848x848px
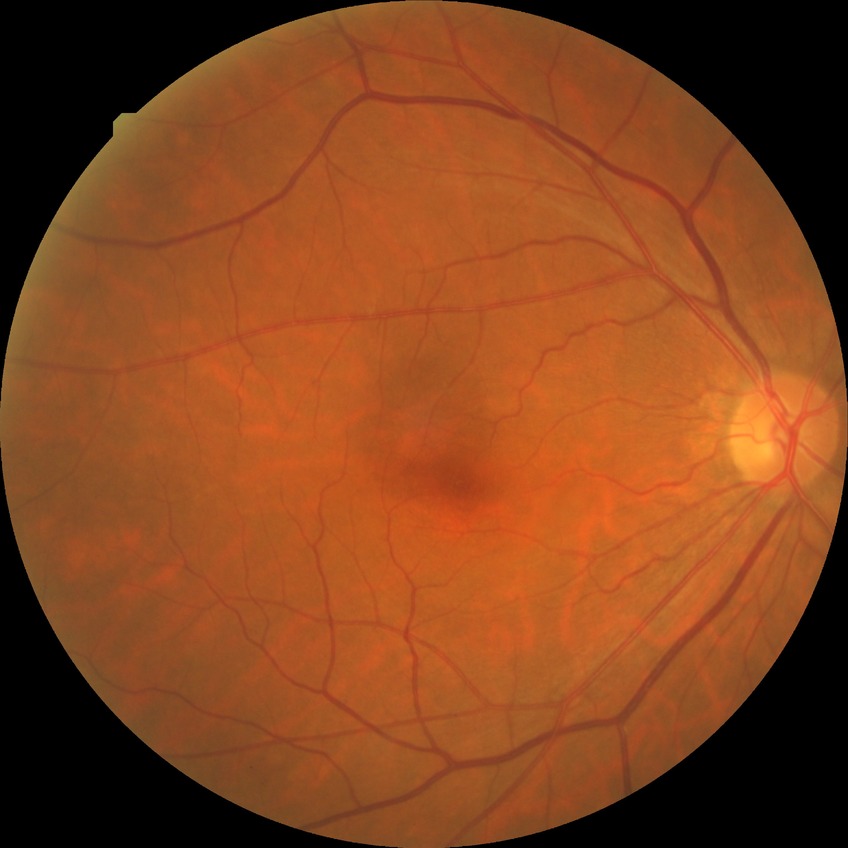

modified Davis grade: NDR, DR impression: no apparent DR.